2089x1764.
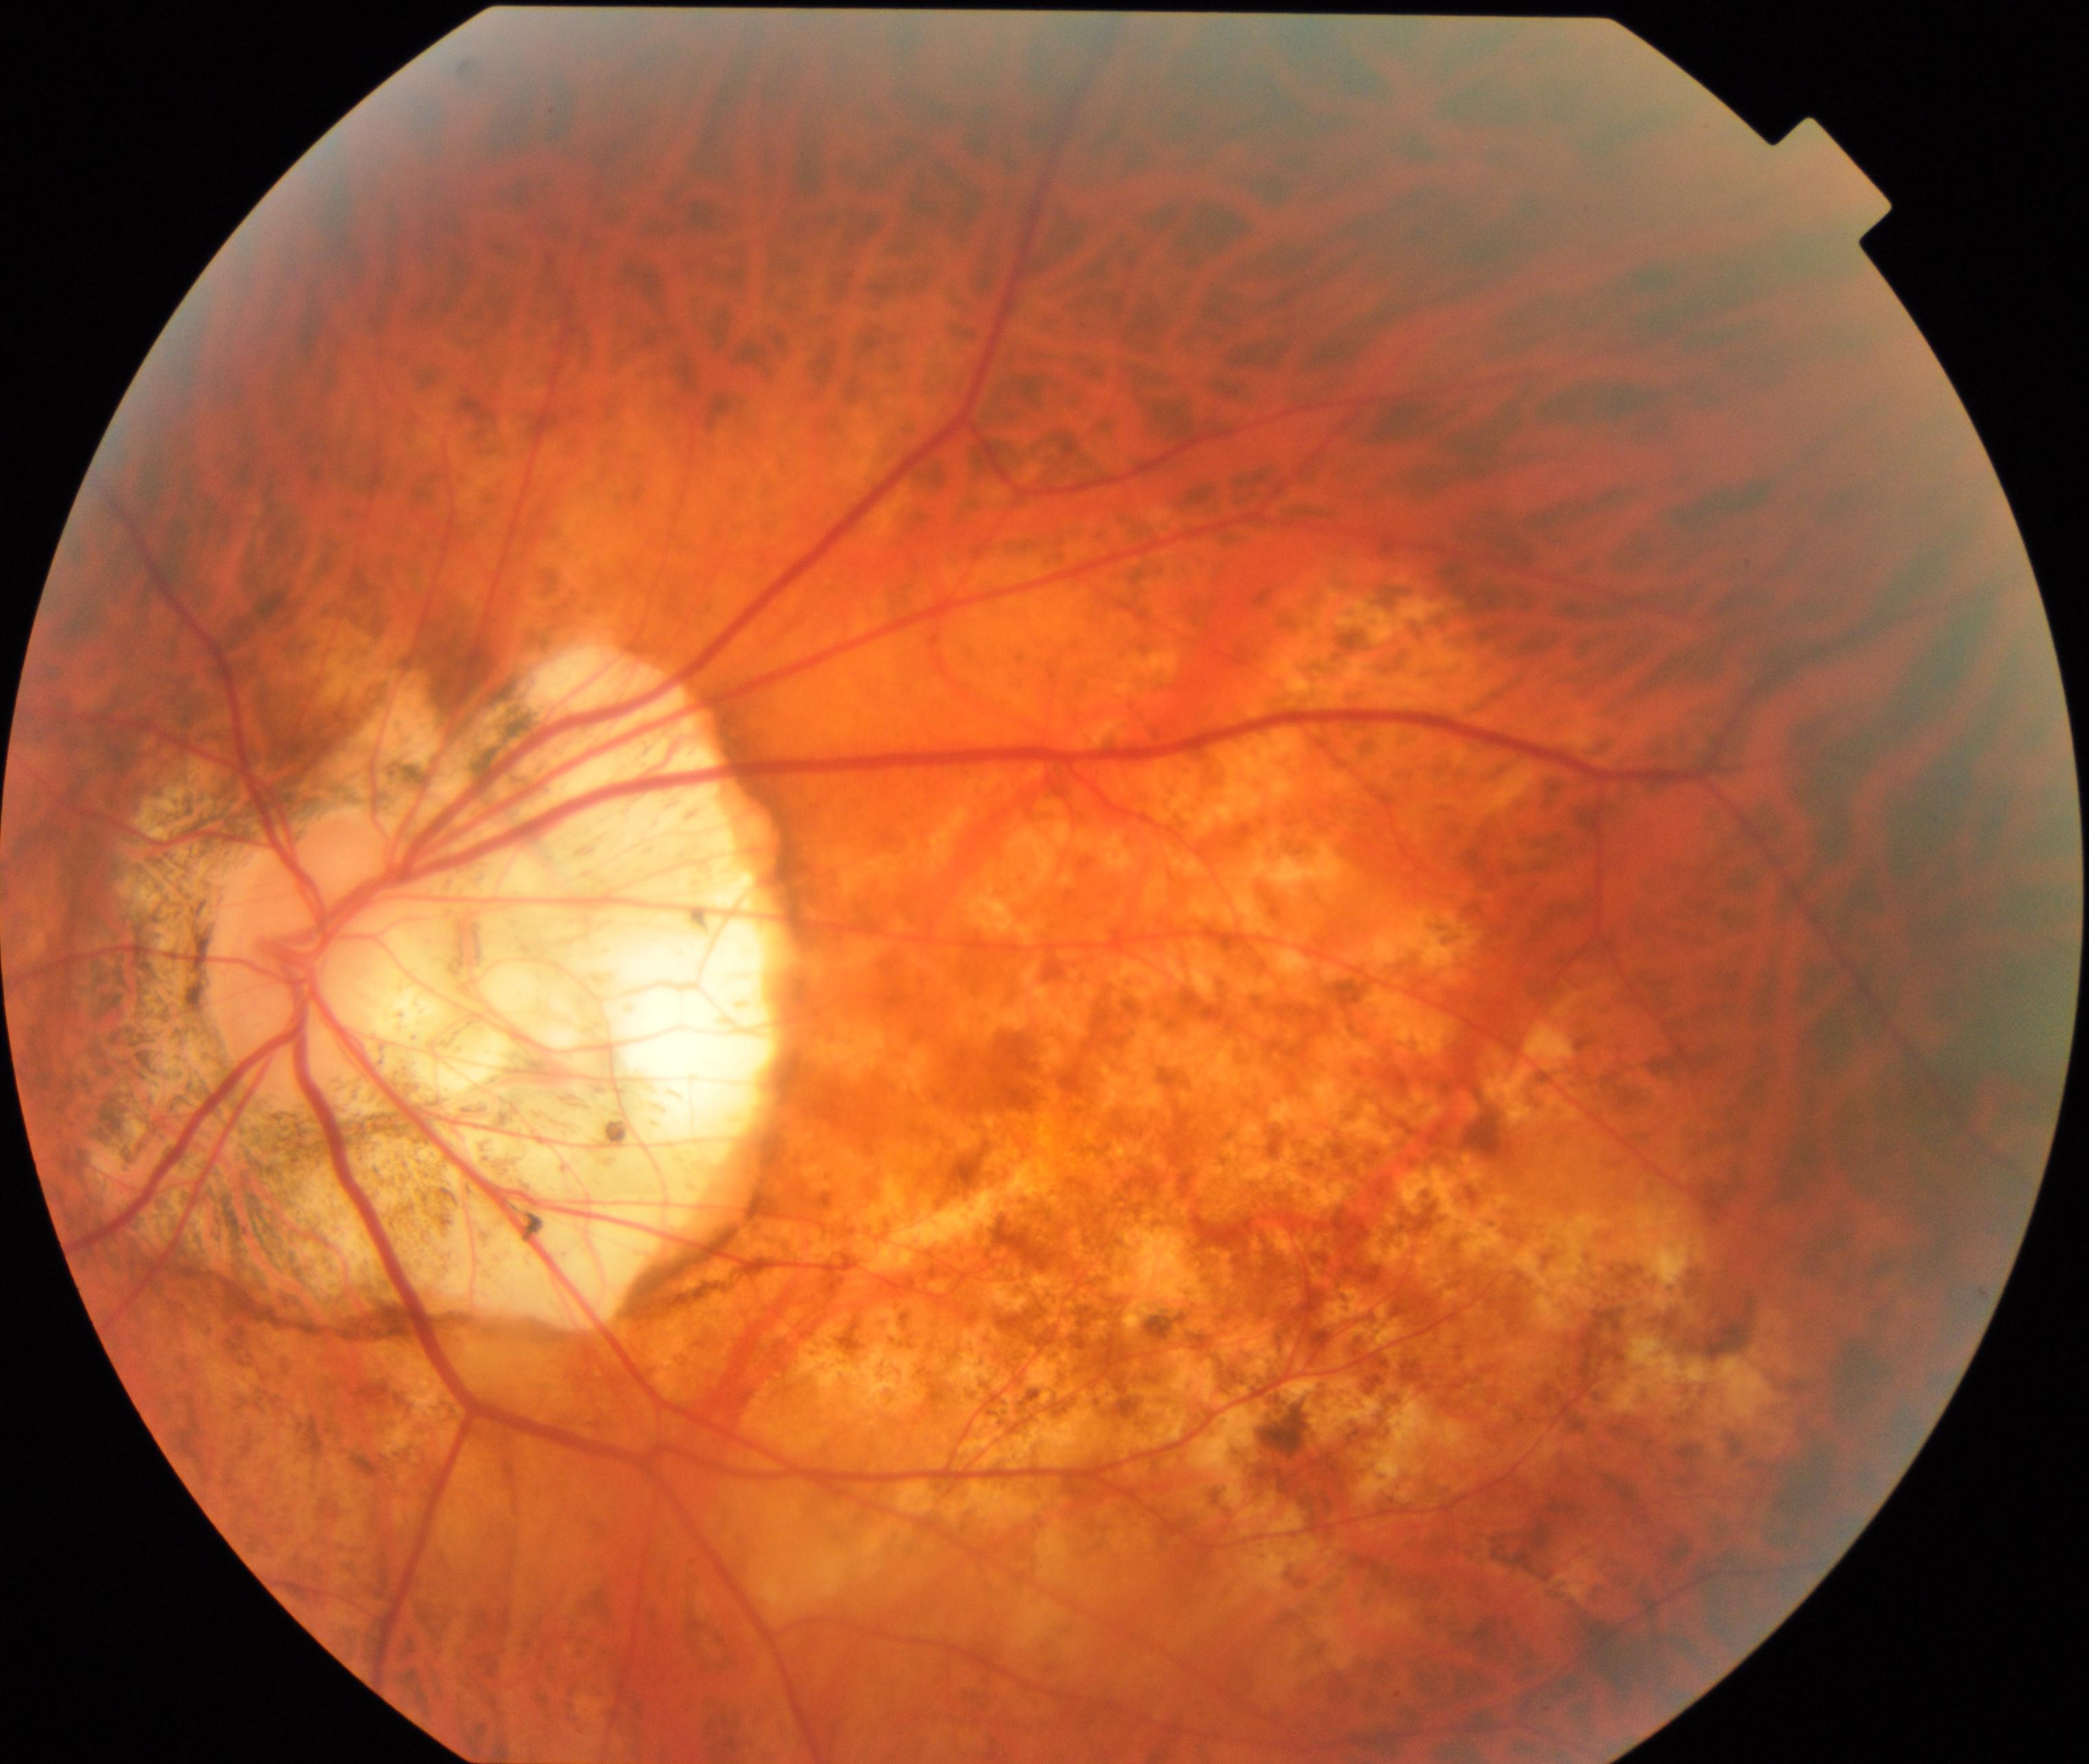
Findings consistent with pathological myopia.